45° FOV, 1725 by 1721 pixels.
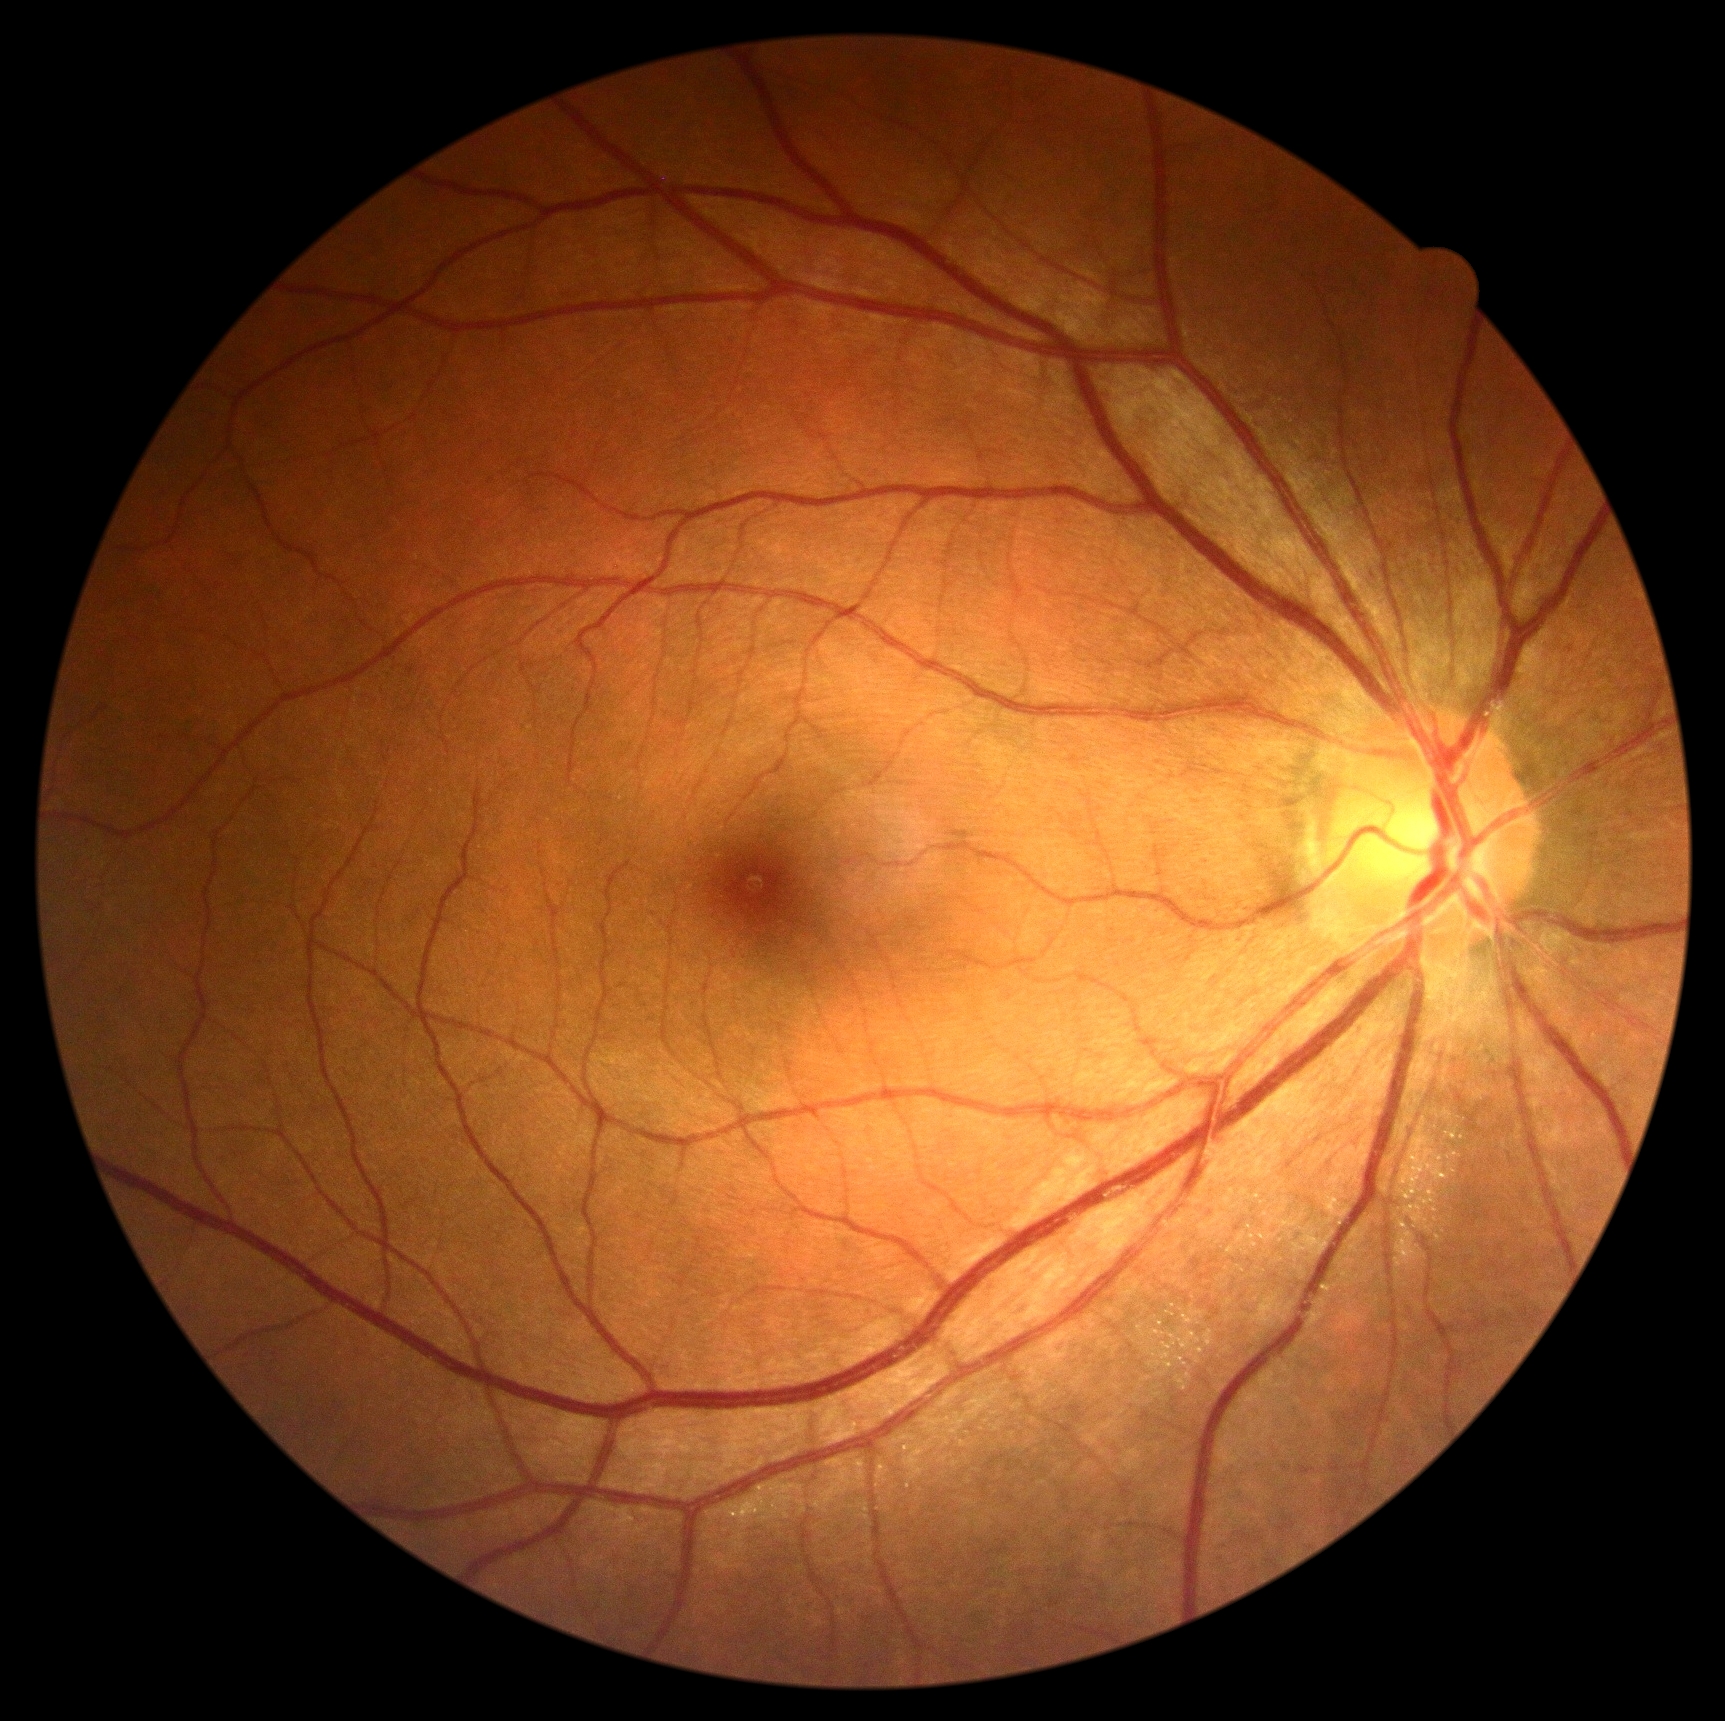 No apparent diabetic retinopathy.
Diabetic retinopathy (DR): grade 0 (no apparent retinopathy).